Wide-field fundus photograph from neonatal ROP screening; captured with the Natus RetCam Envision (130° field of view): 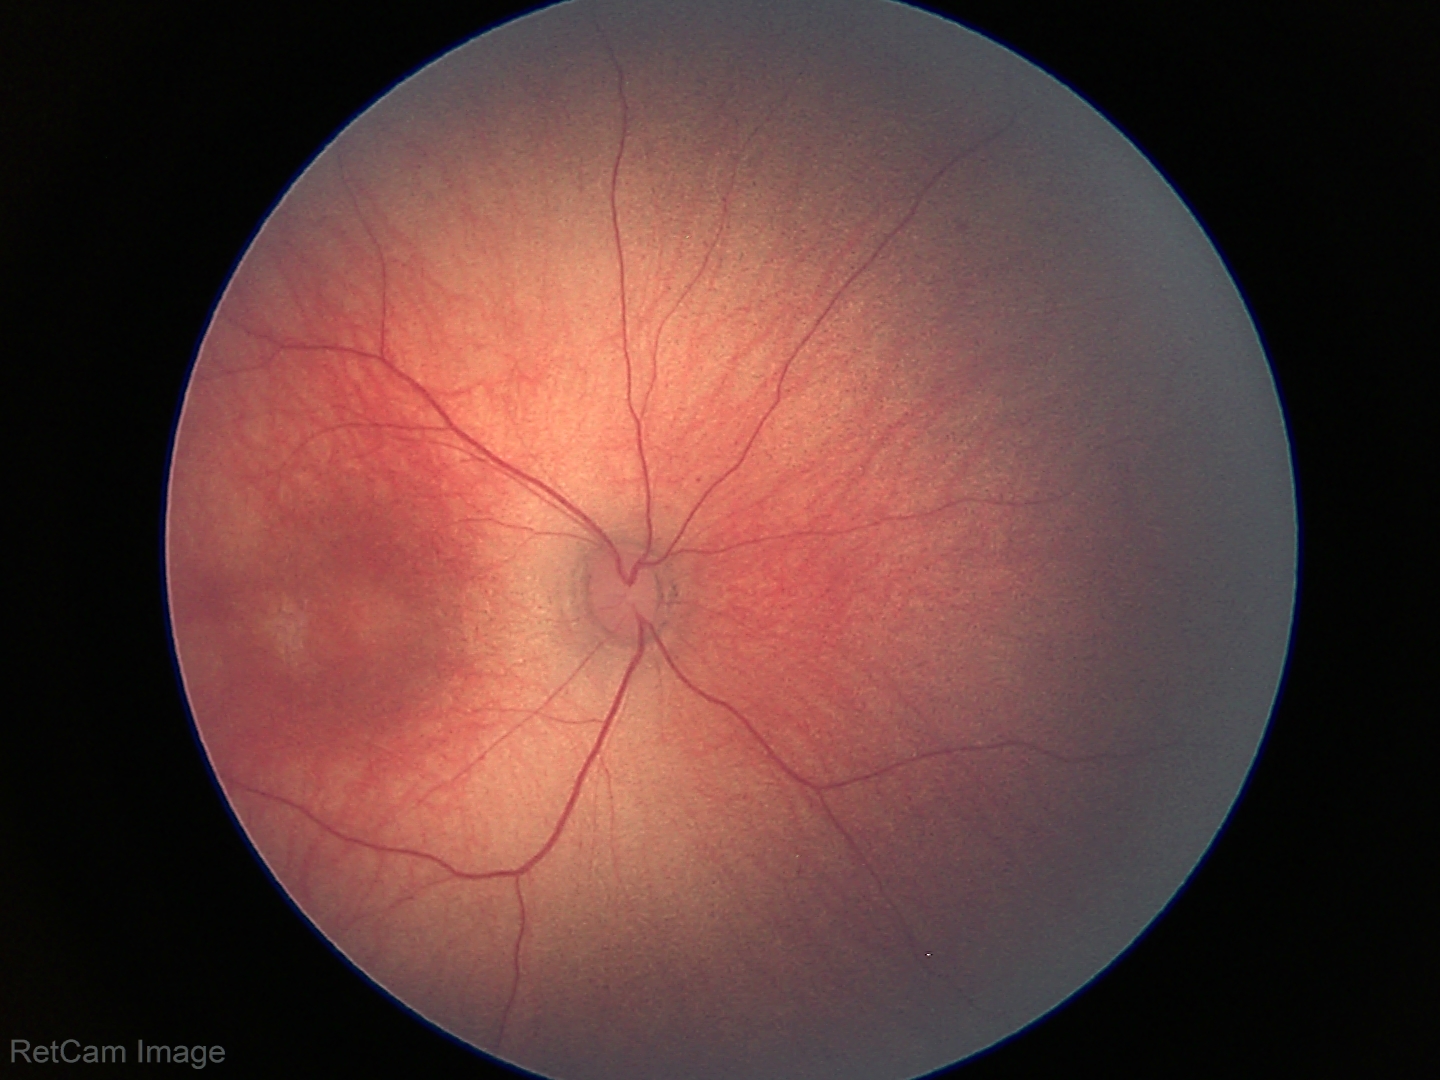
Diagnosis: no abnormalities